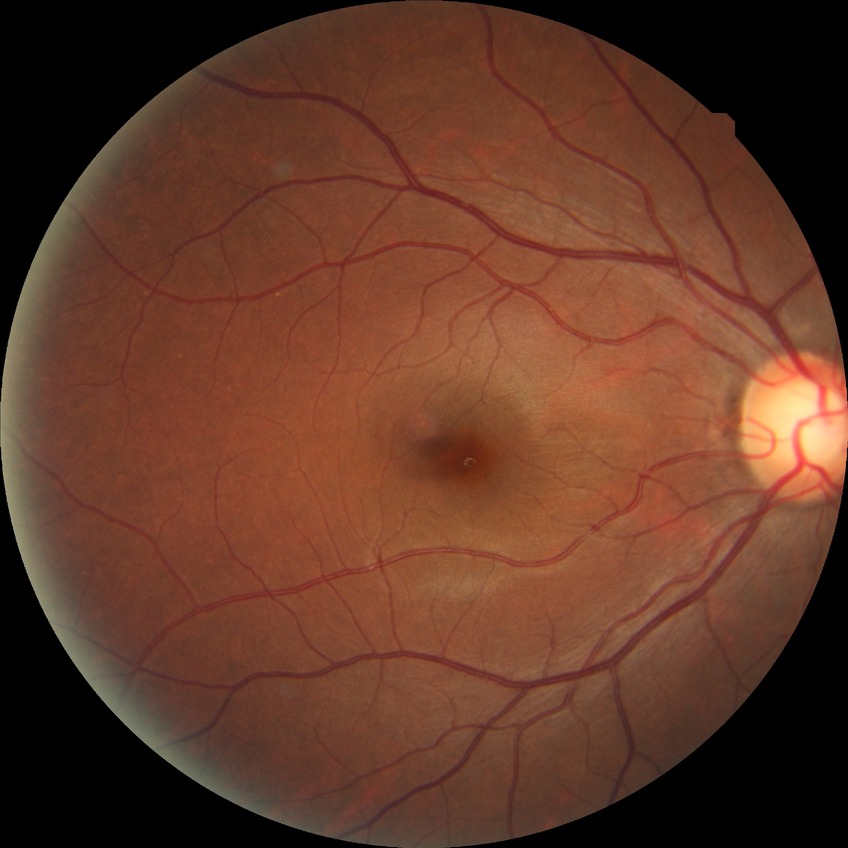

Diabetic retinopathy (DR): NDR (no diabetic retinopathy).